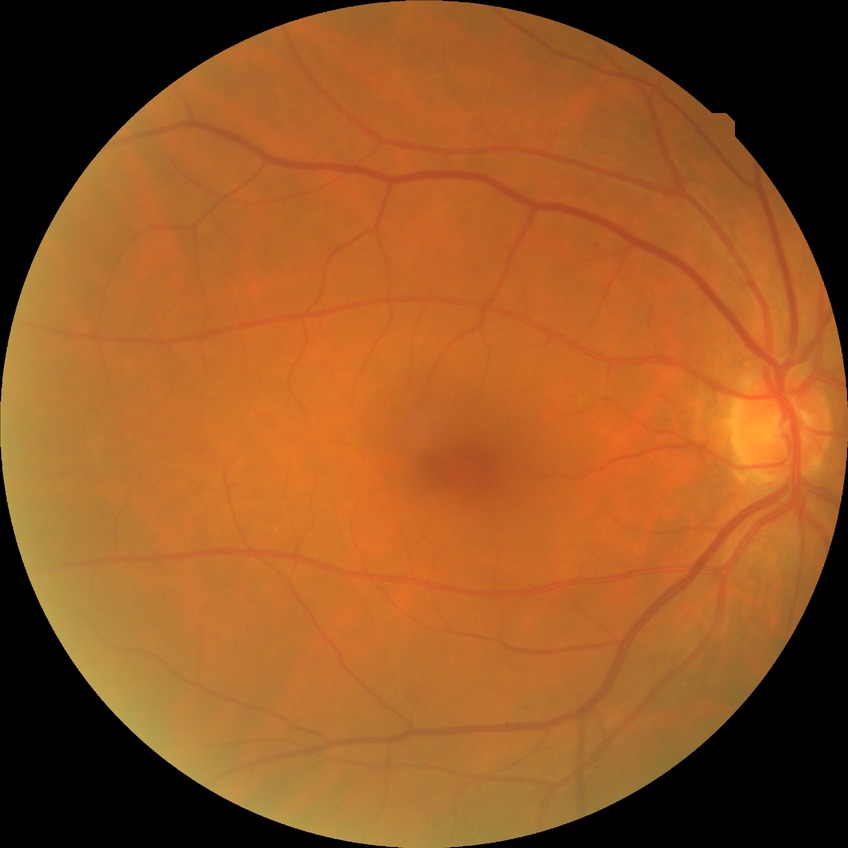 davis_grade: SDR